Color fundus photograph.
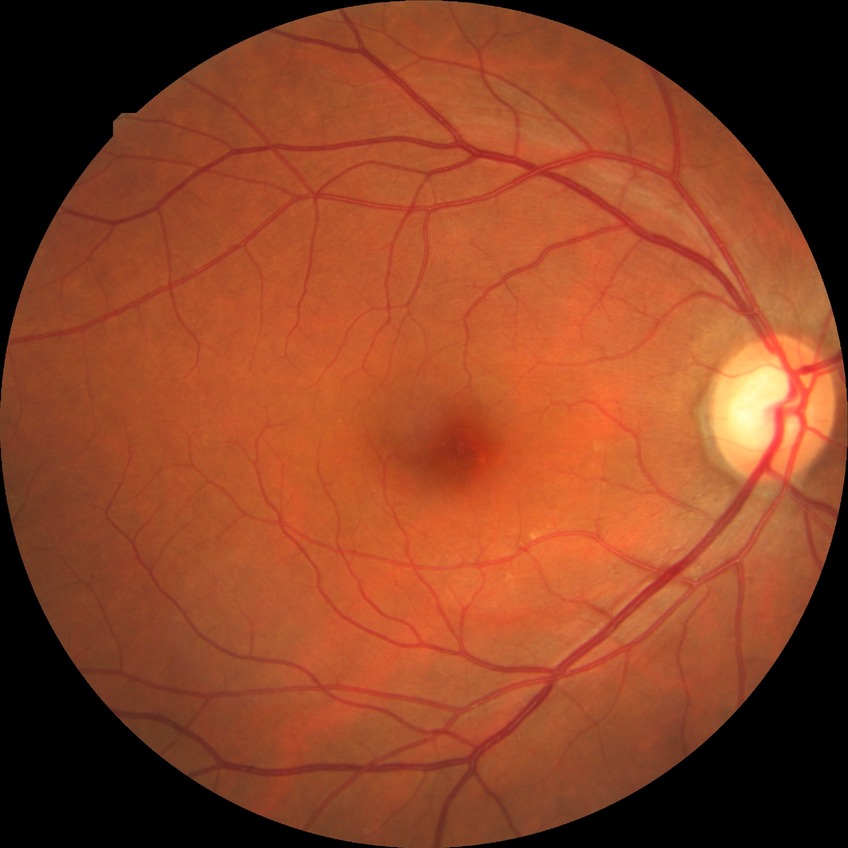

Diabetic retinopathy (DR): no diabetic retinopathy (NDR).